Dilated pupil. Topcon TRC fundus camera. Optic disc region of a color fundus photo.
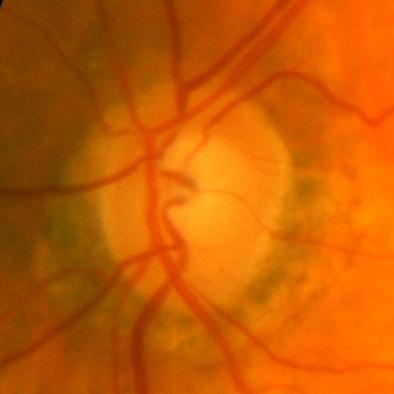 Diagnosis = no evidence of glaucoma.